RetCam wide-field infant fundus image.
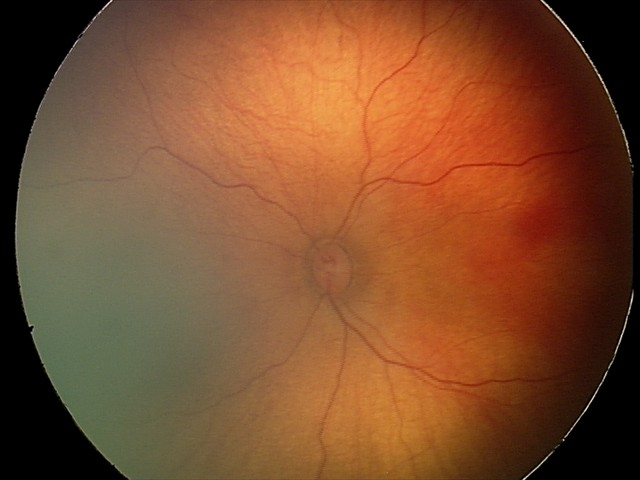 Screening diagnosis: no abnormalities.